FOV: 45 degrees — 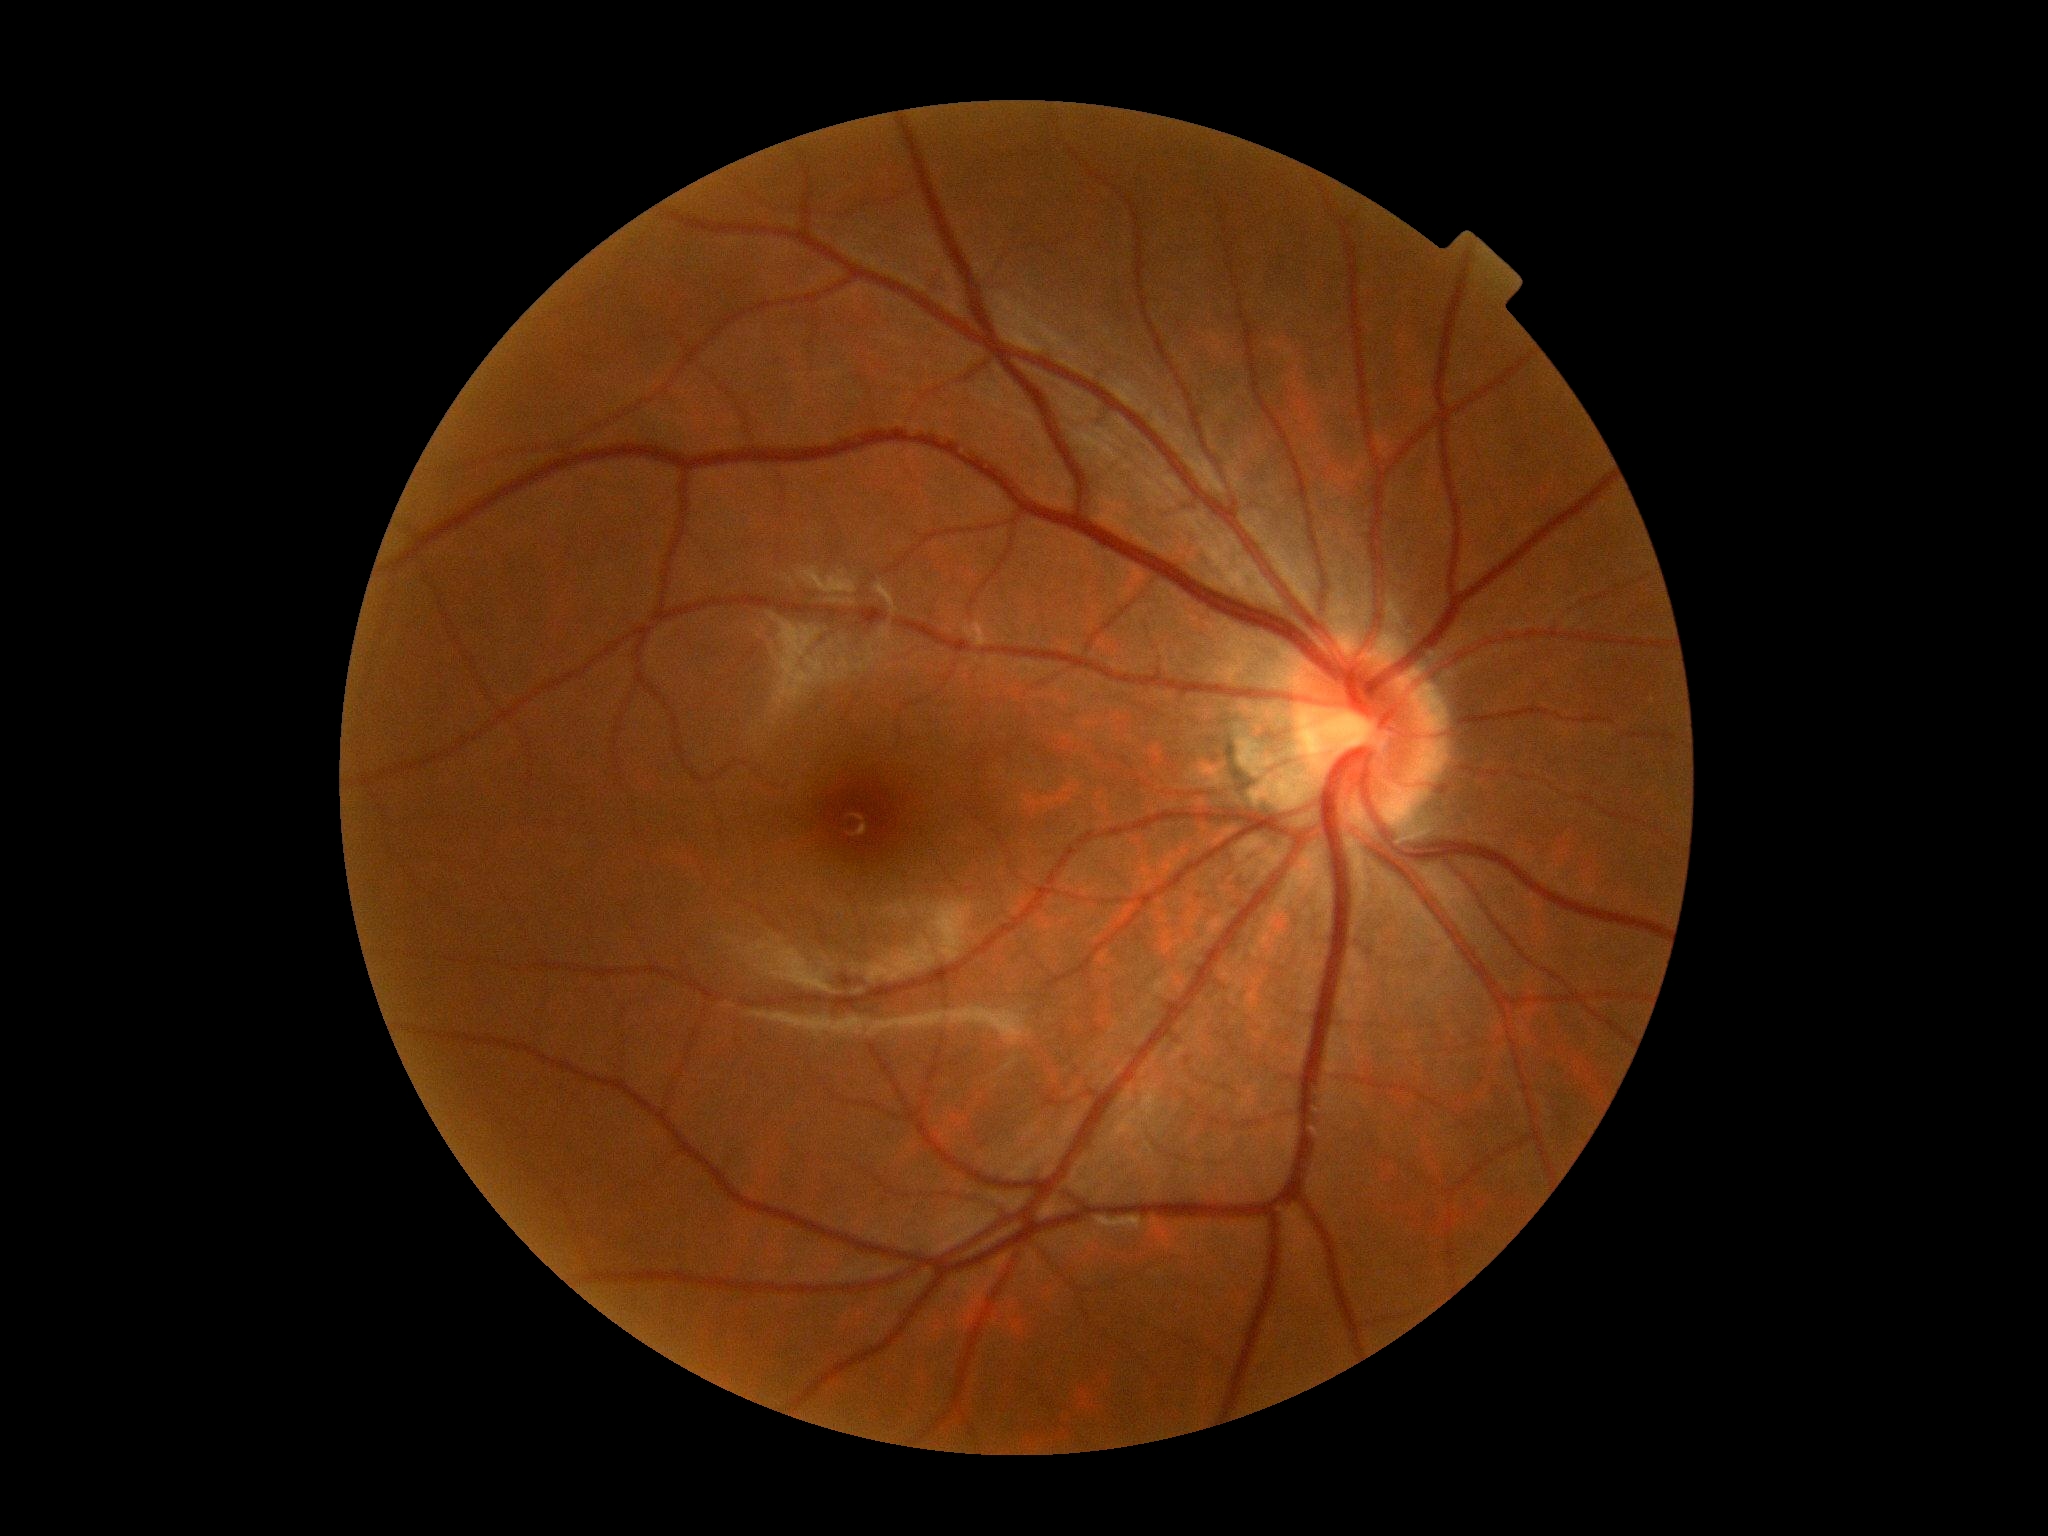

DR severity is no apparent retinopathy (grade 0).